Image size 2352x1568 — 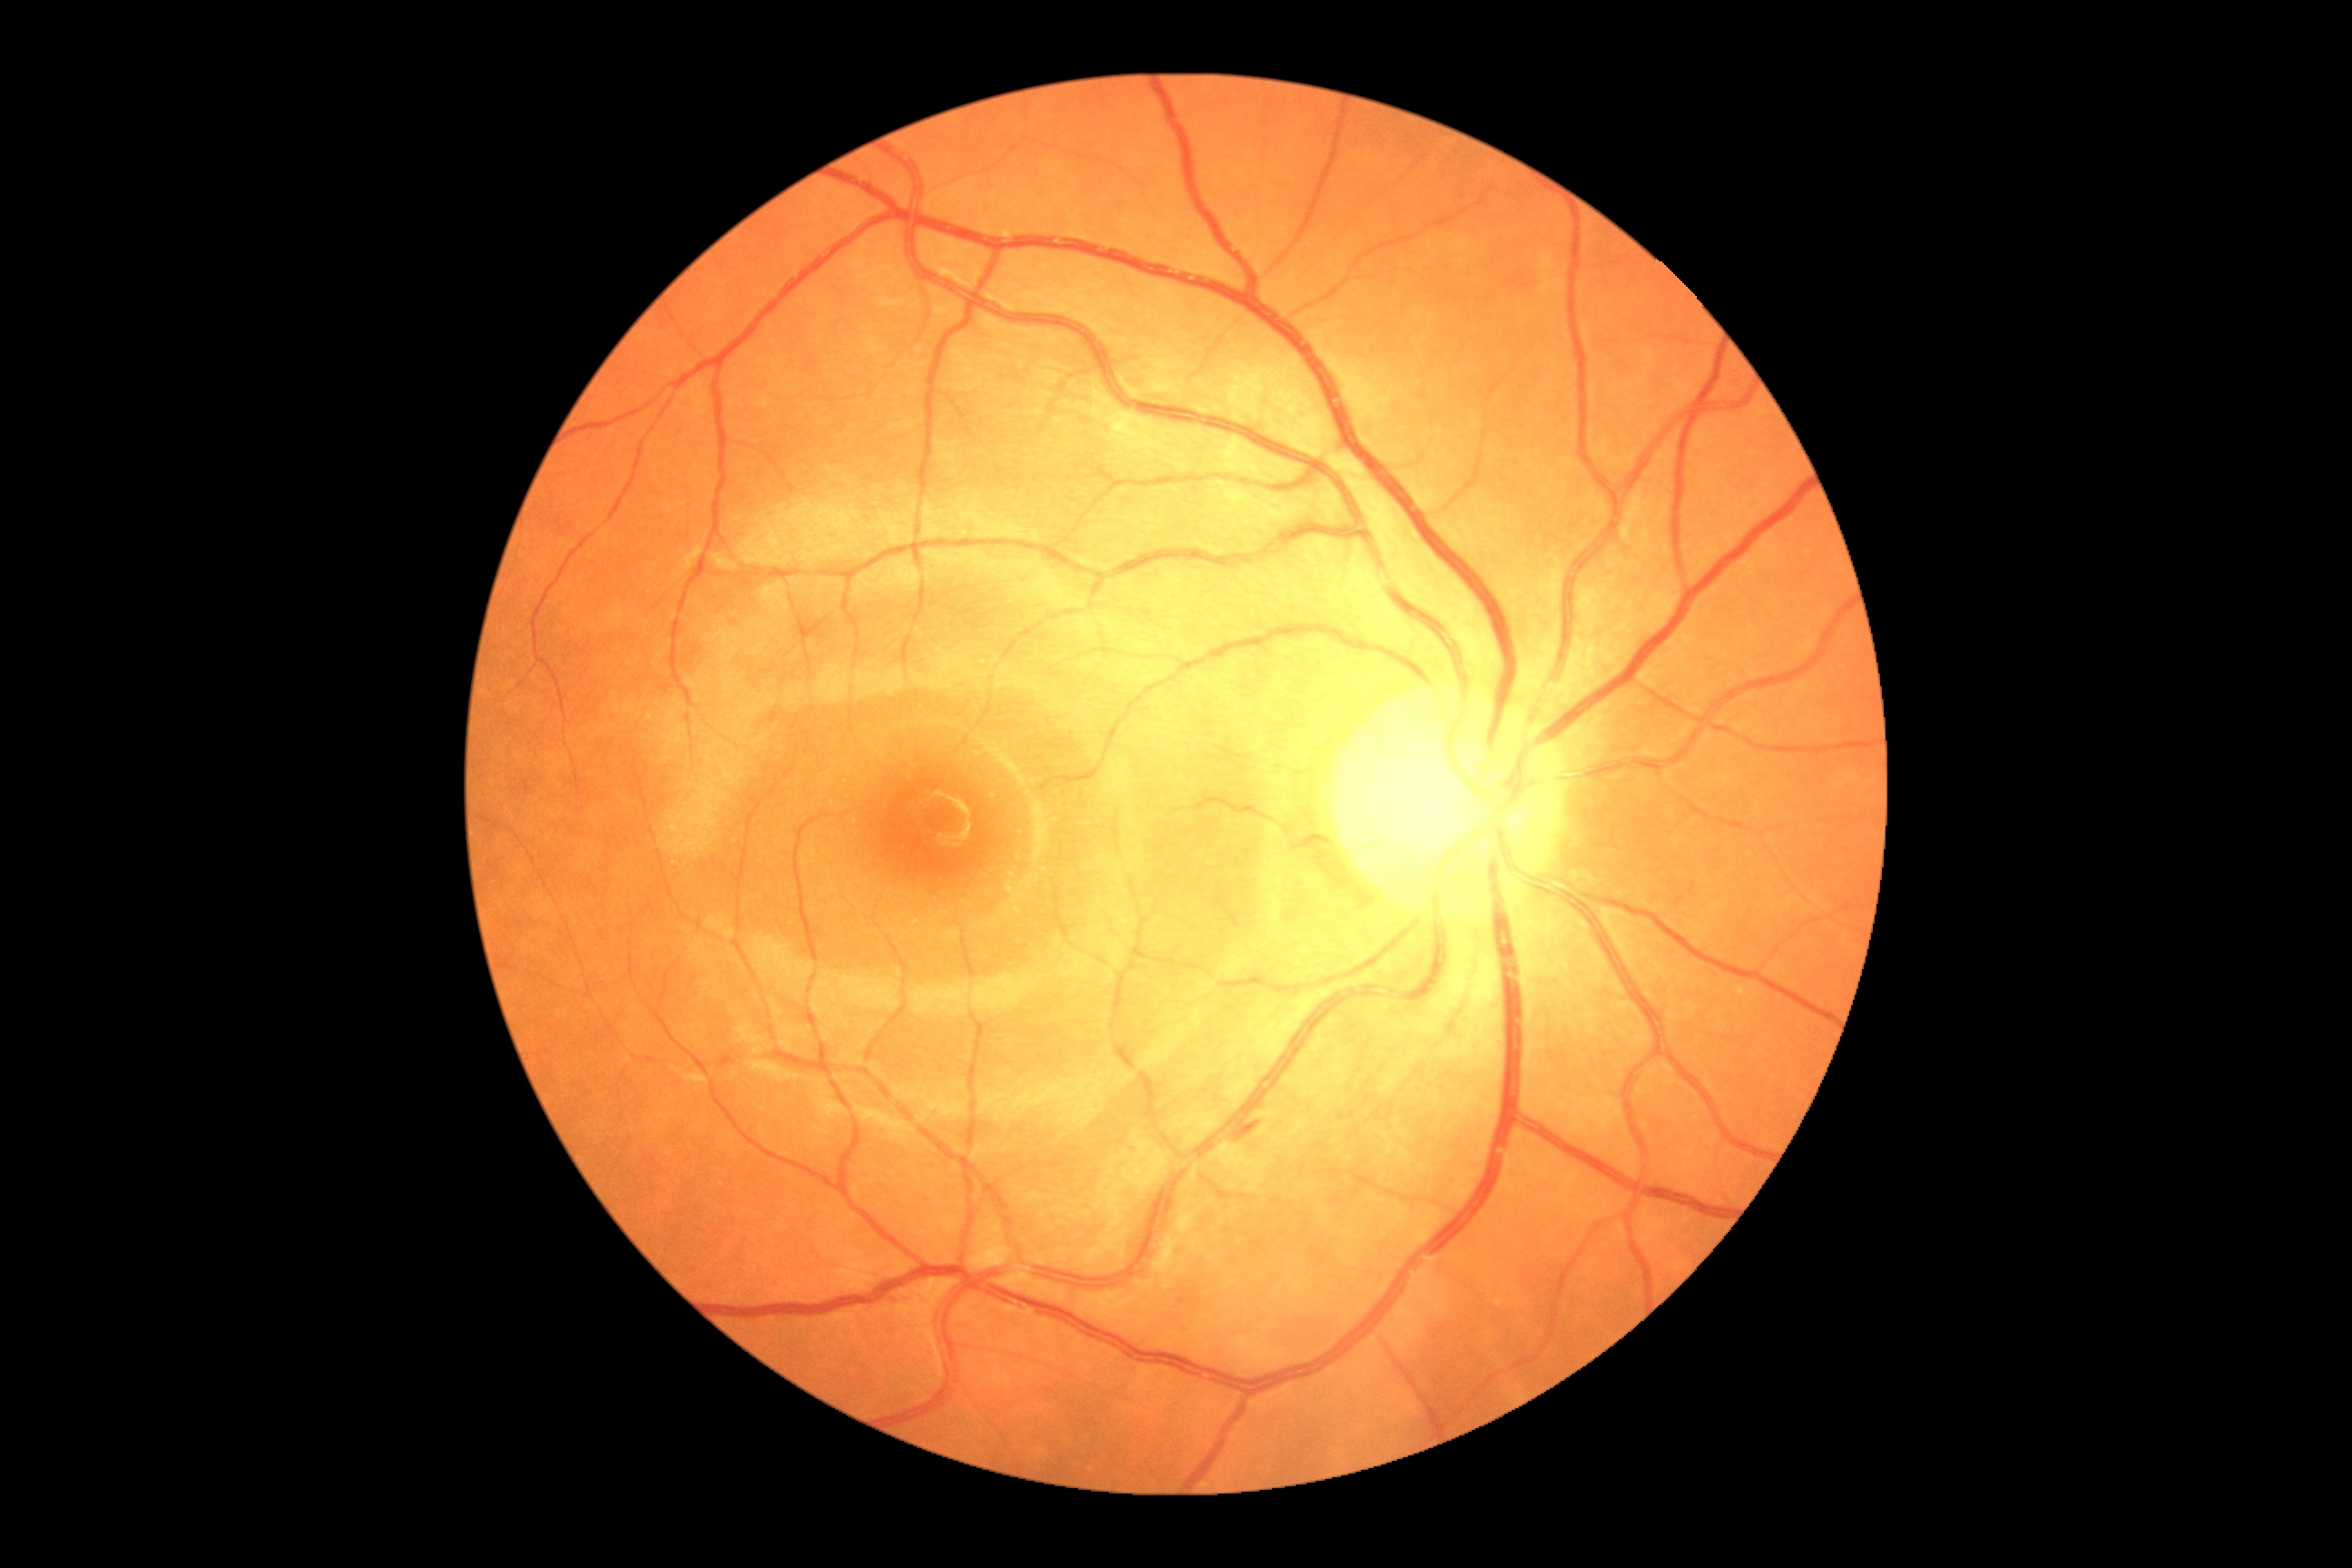
Diabetic retinopathy is grade 2 (moderate NPDR).